NIDEK AFC-230
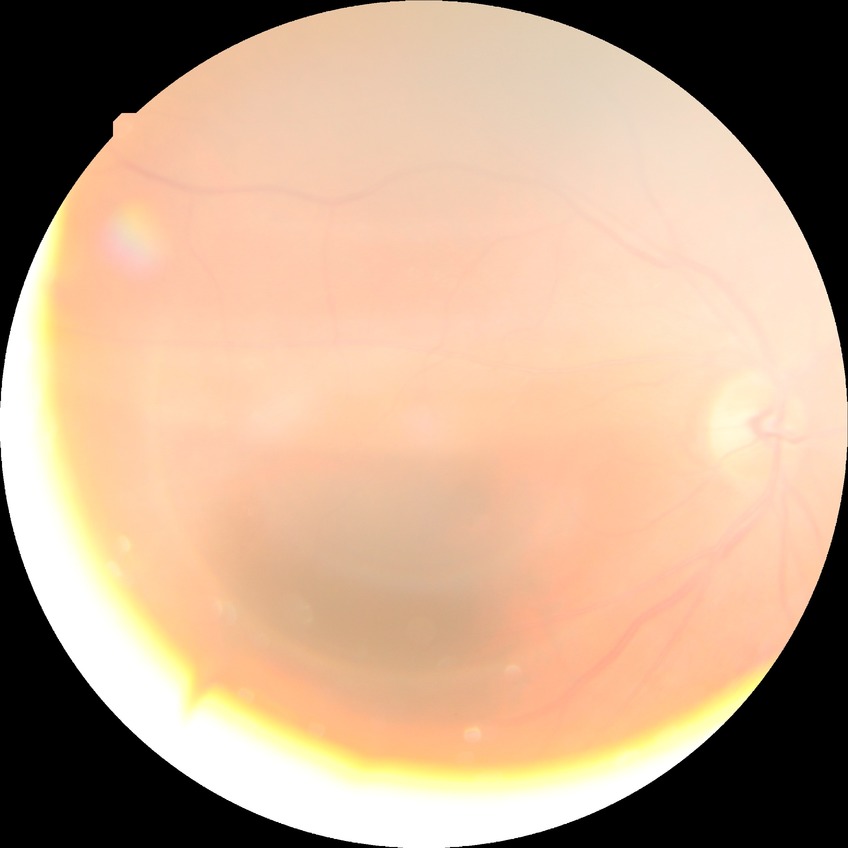

davis_grade: NDR (no diabetic retinopathy)